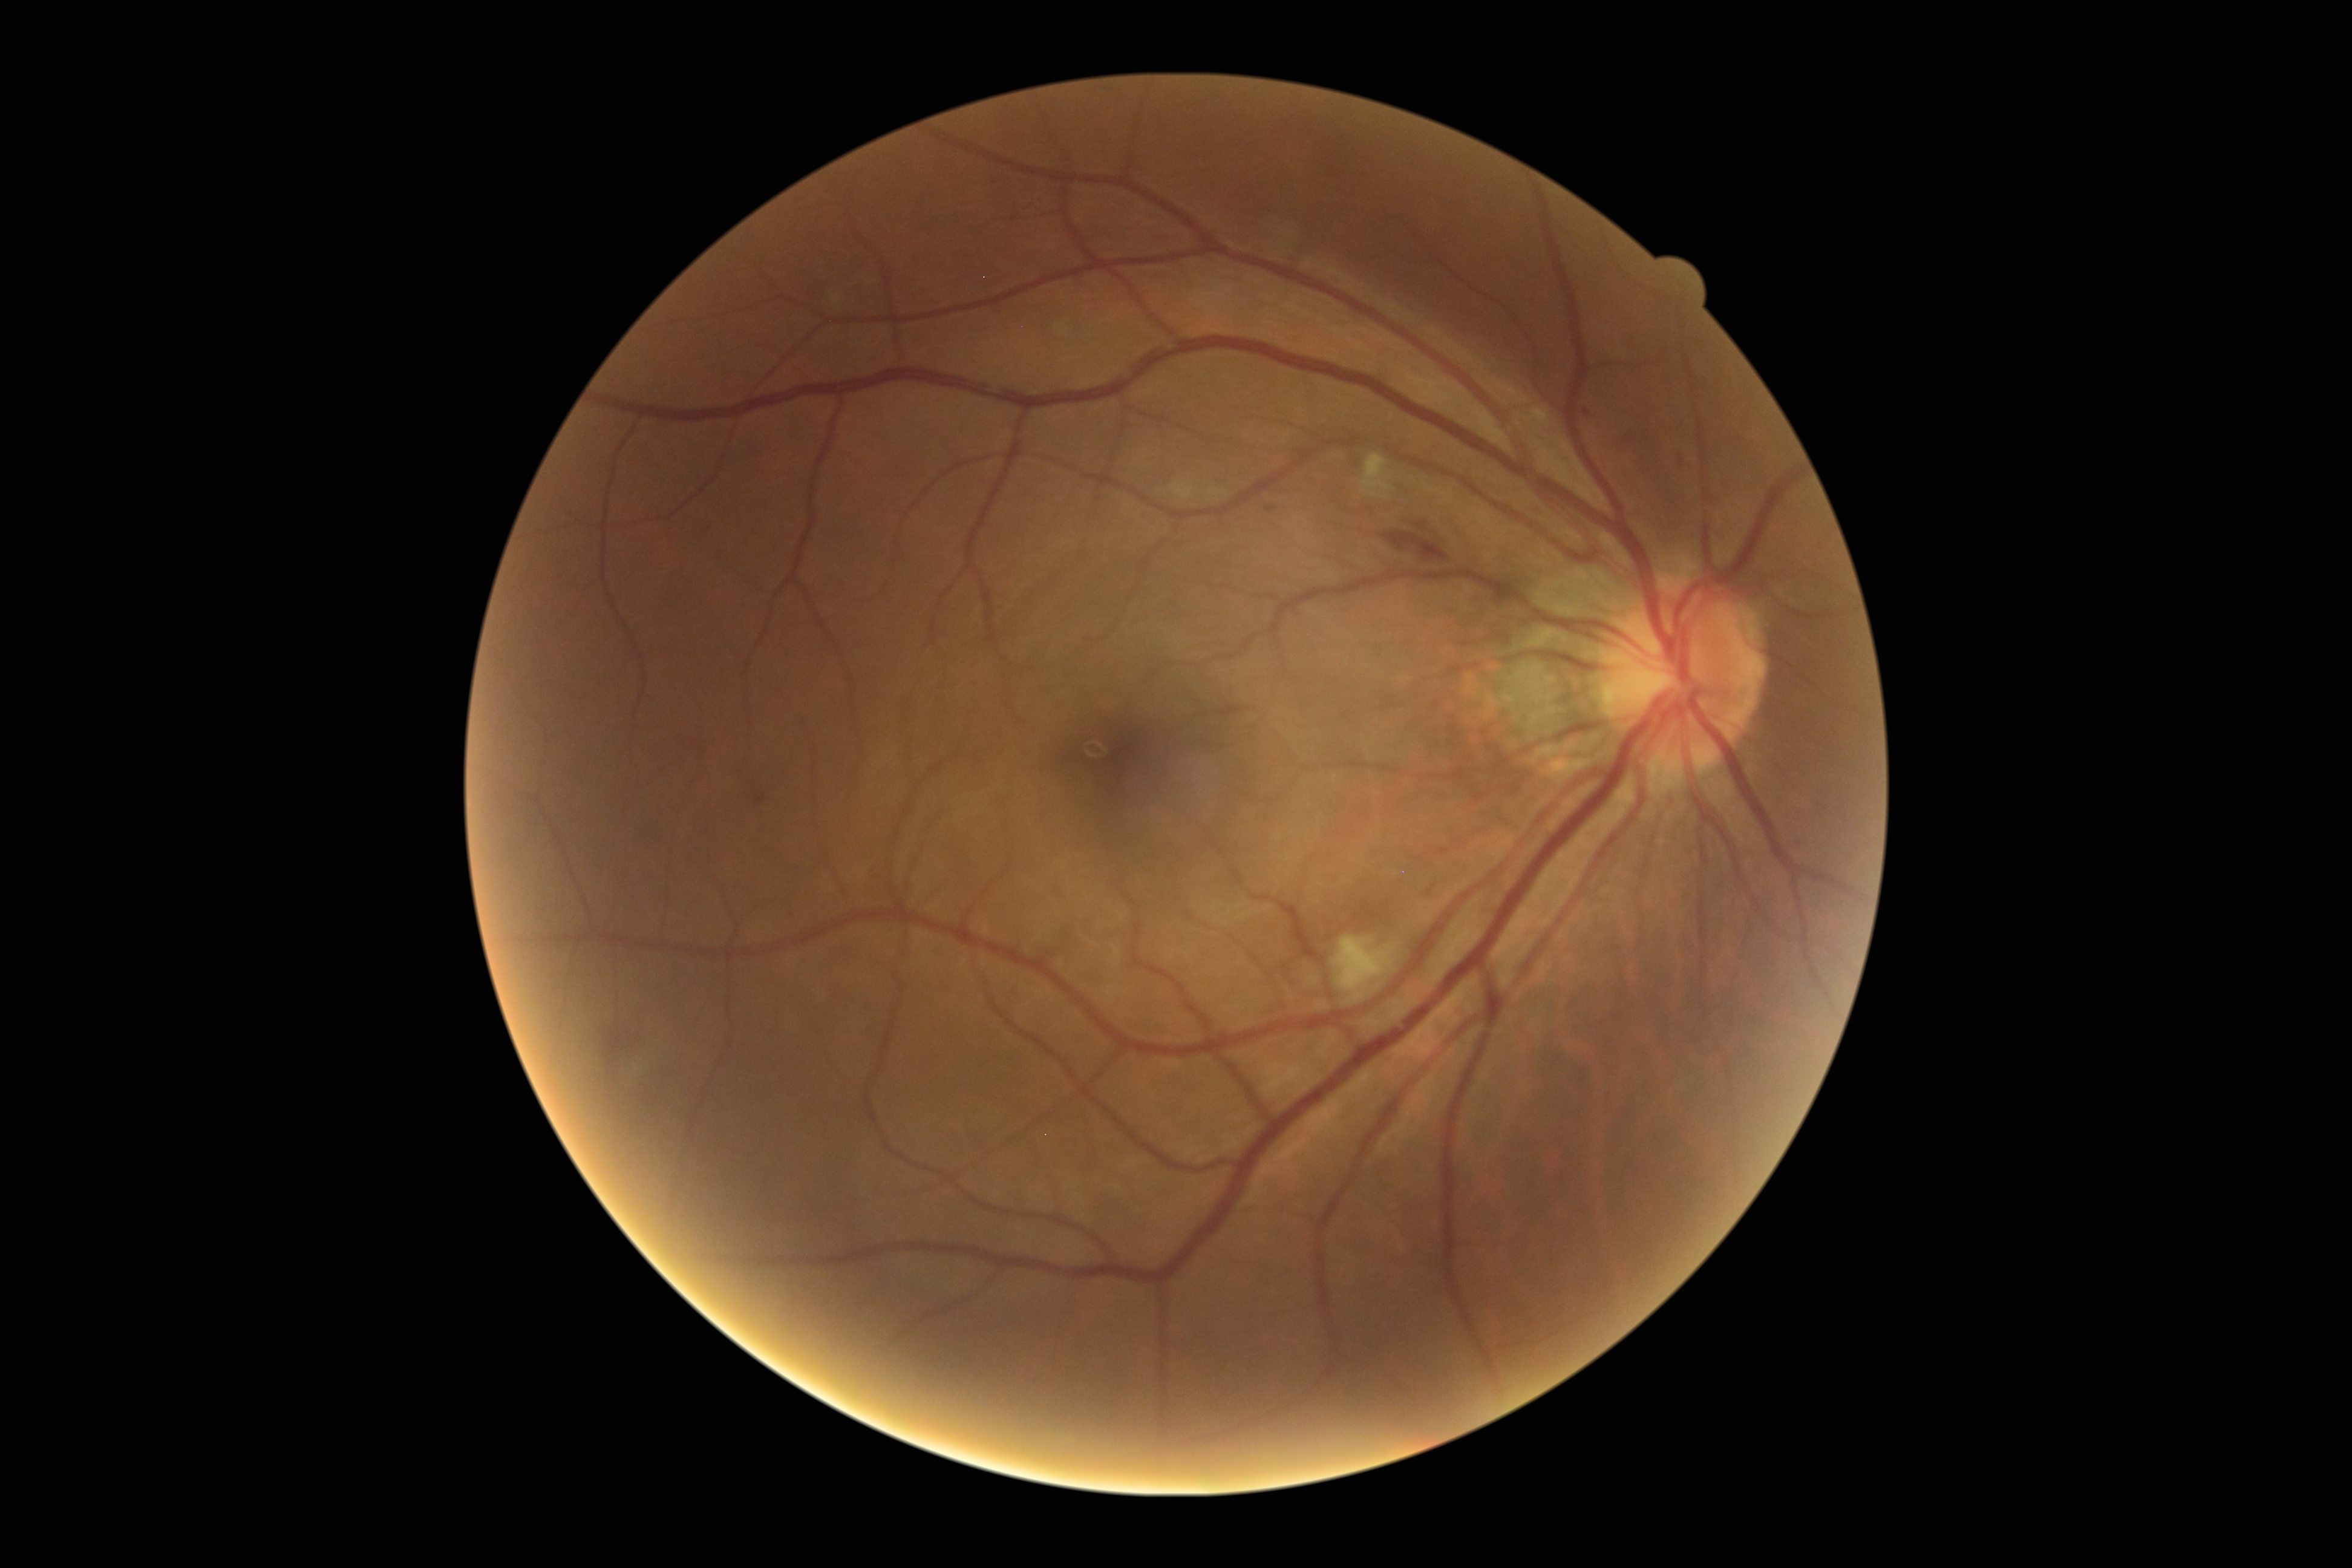

Diabetic retinopathy: grade 2.